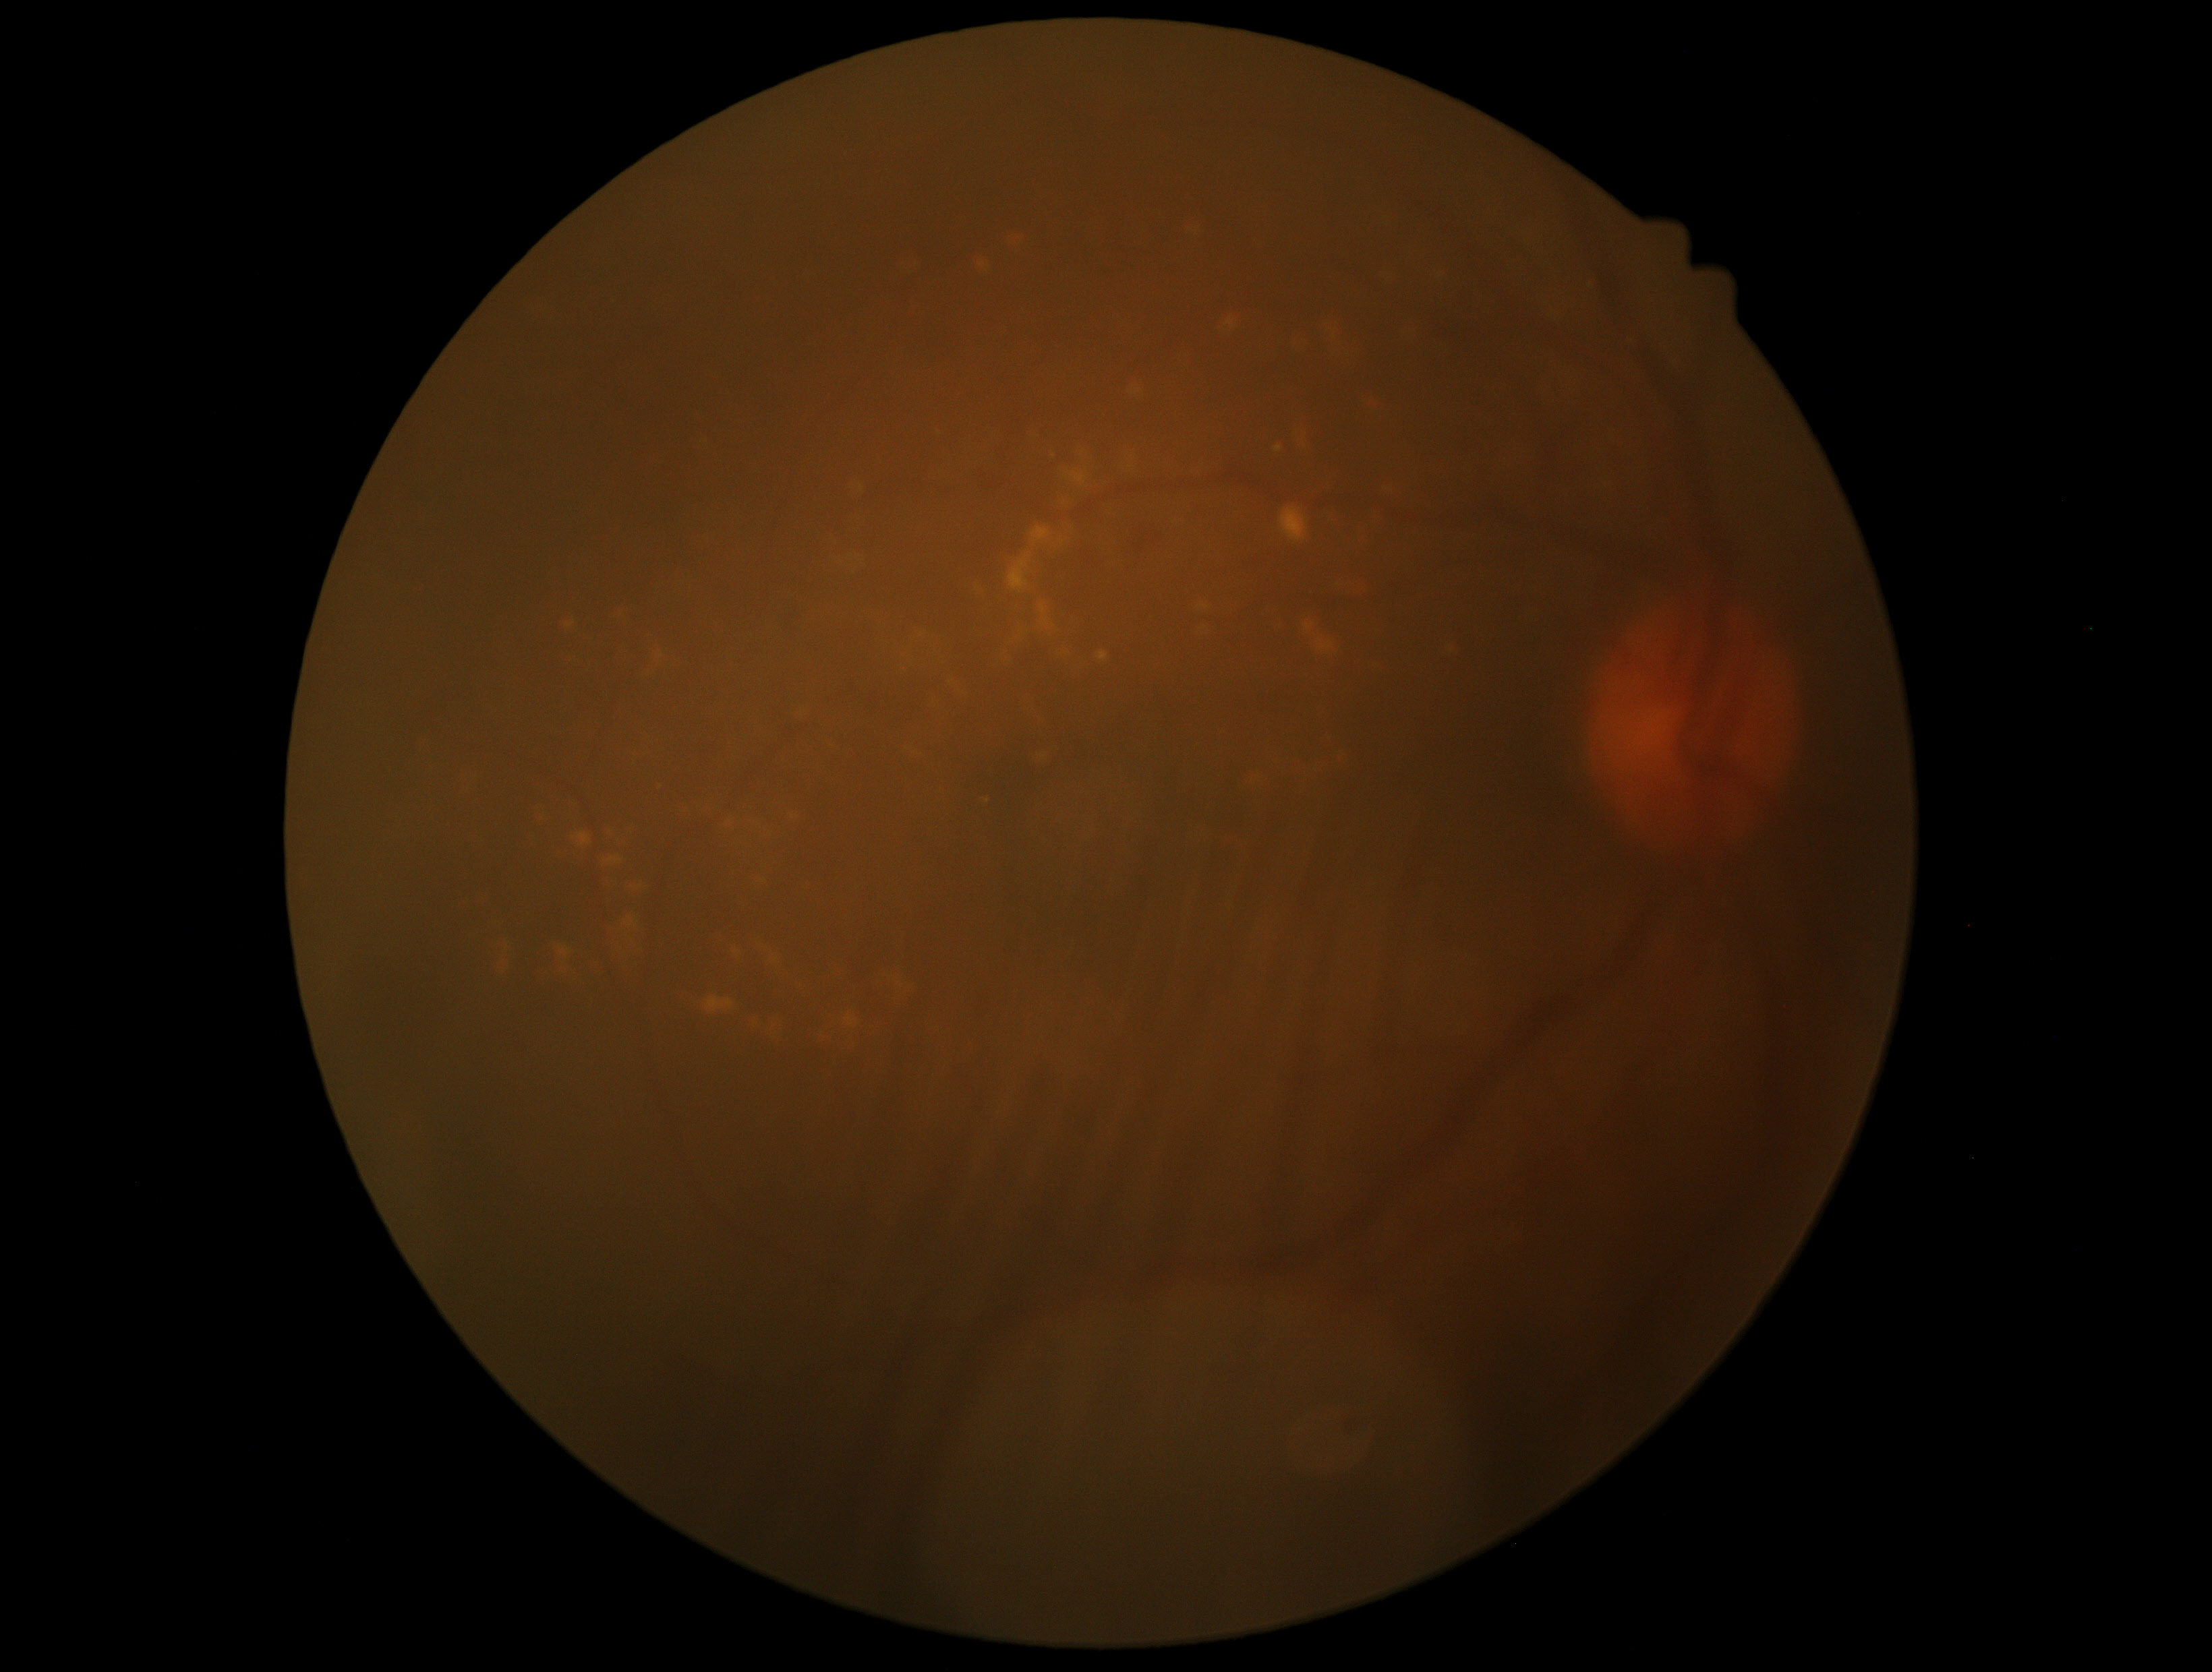 Annotations:
– diabetic retinopathy (DR) — 2/4 — more than just microaneurysms but less than severe NPDR
– DR class — non-proliferative diabetic retinopathy